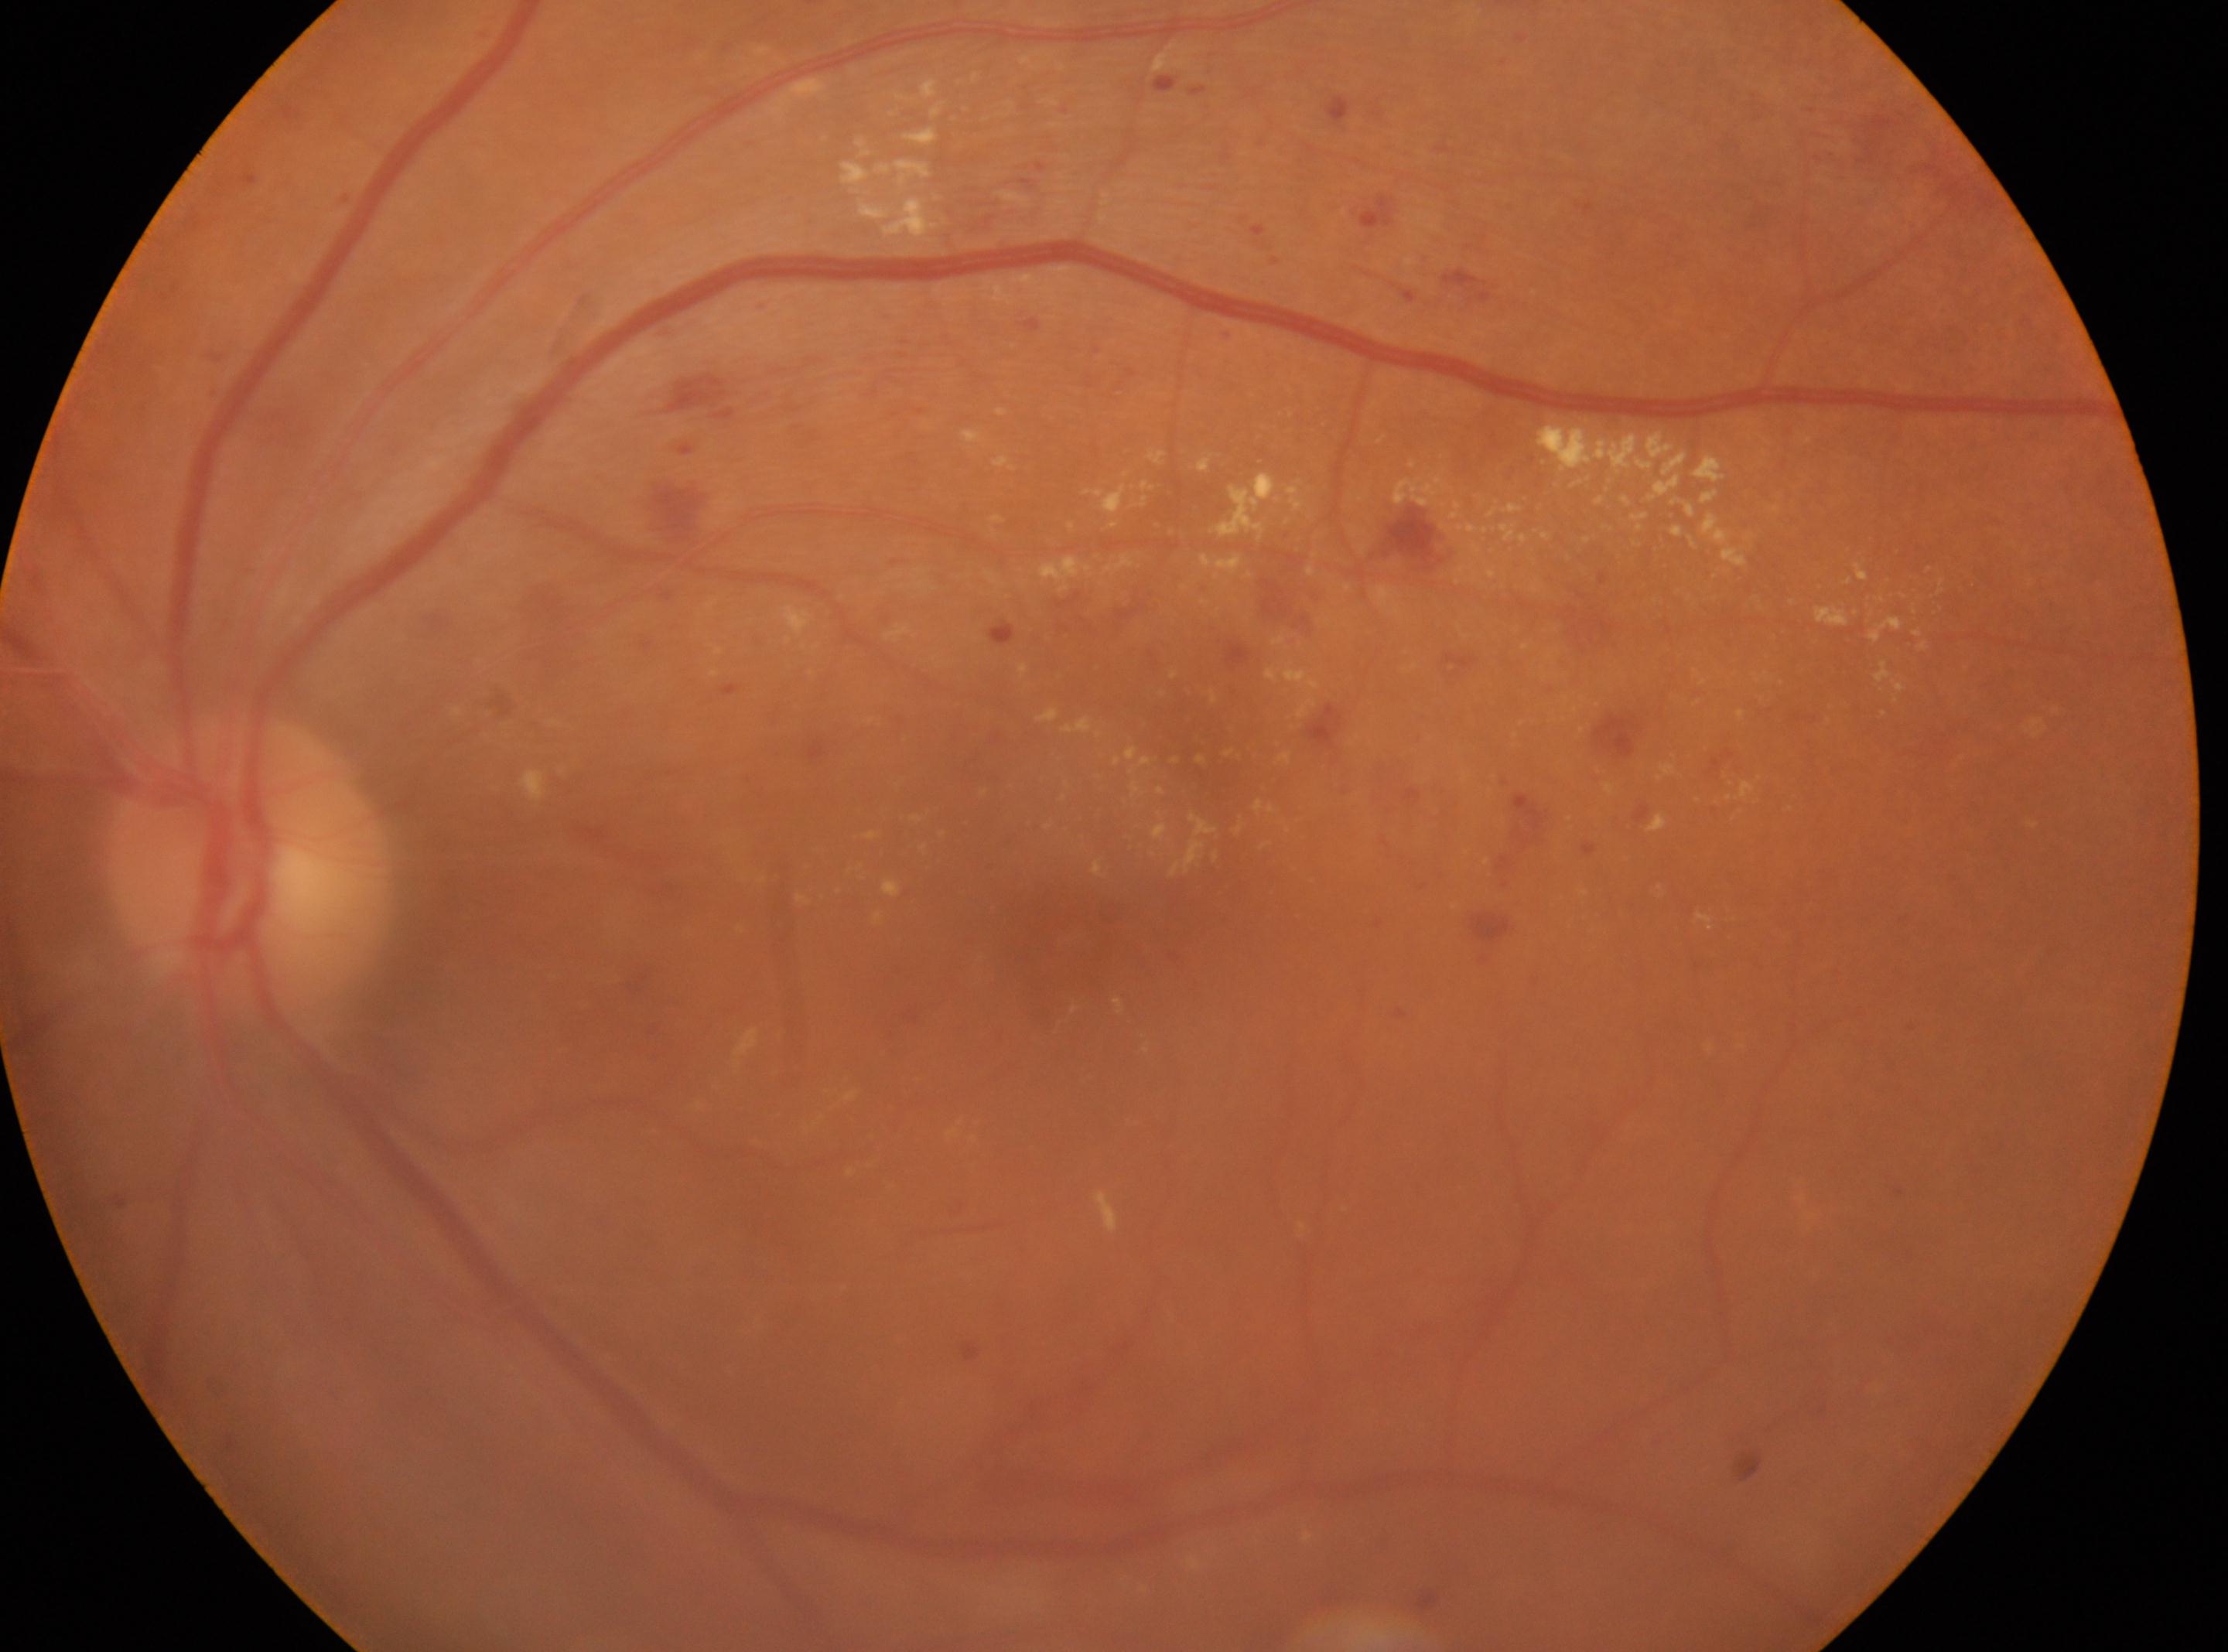 The fovea is at (1083,934).
Optic disk: (249,865).
Diabetic retinopathy (DR) is grade 2 (moderate NPDR).
The image shows the left eye.